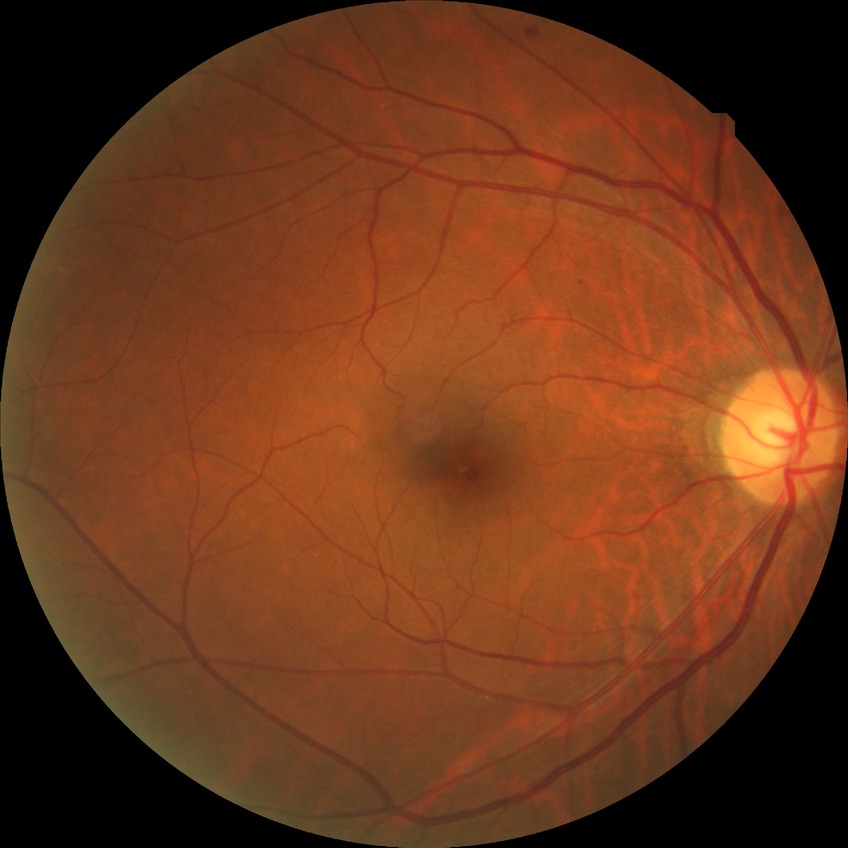

– DR class — non-proliferative diabetic retinopathy
– diabetic retinopathy (DR) — SDR (simple diabetic retinopathy)